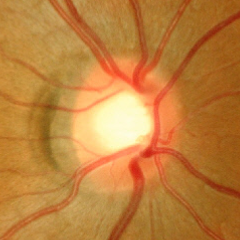

Demonstrates no signs of glaucoma.